Image size 2184x1690.
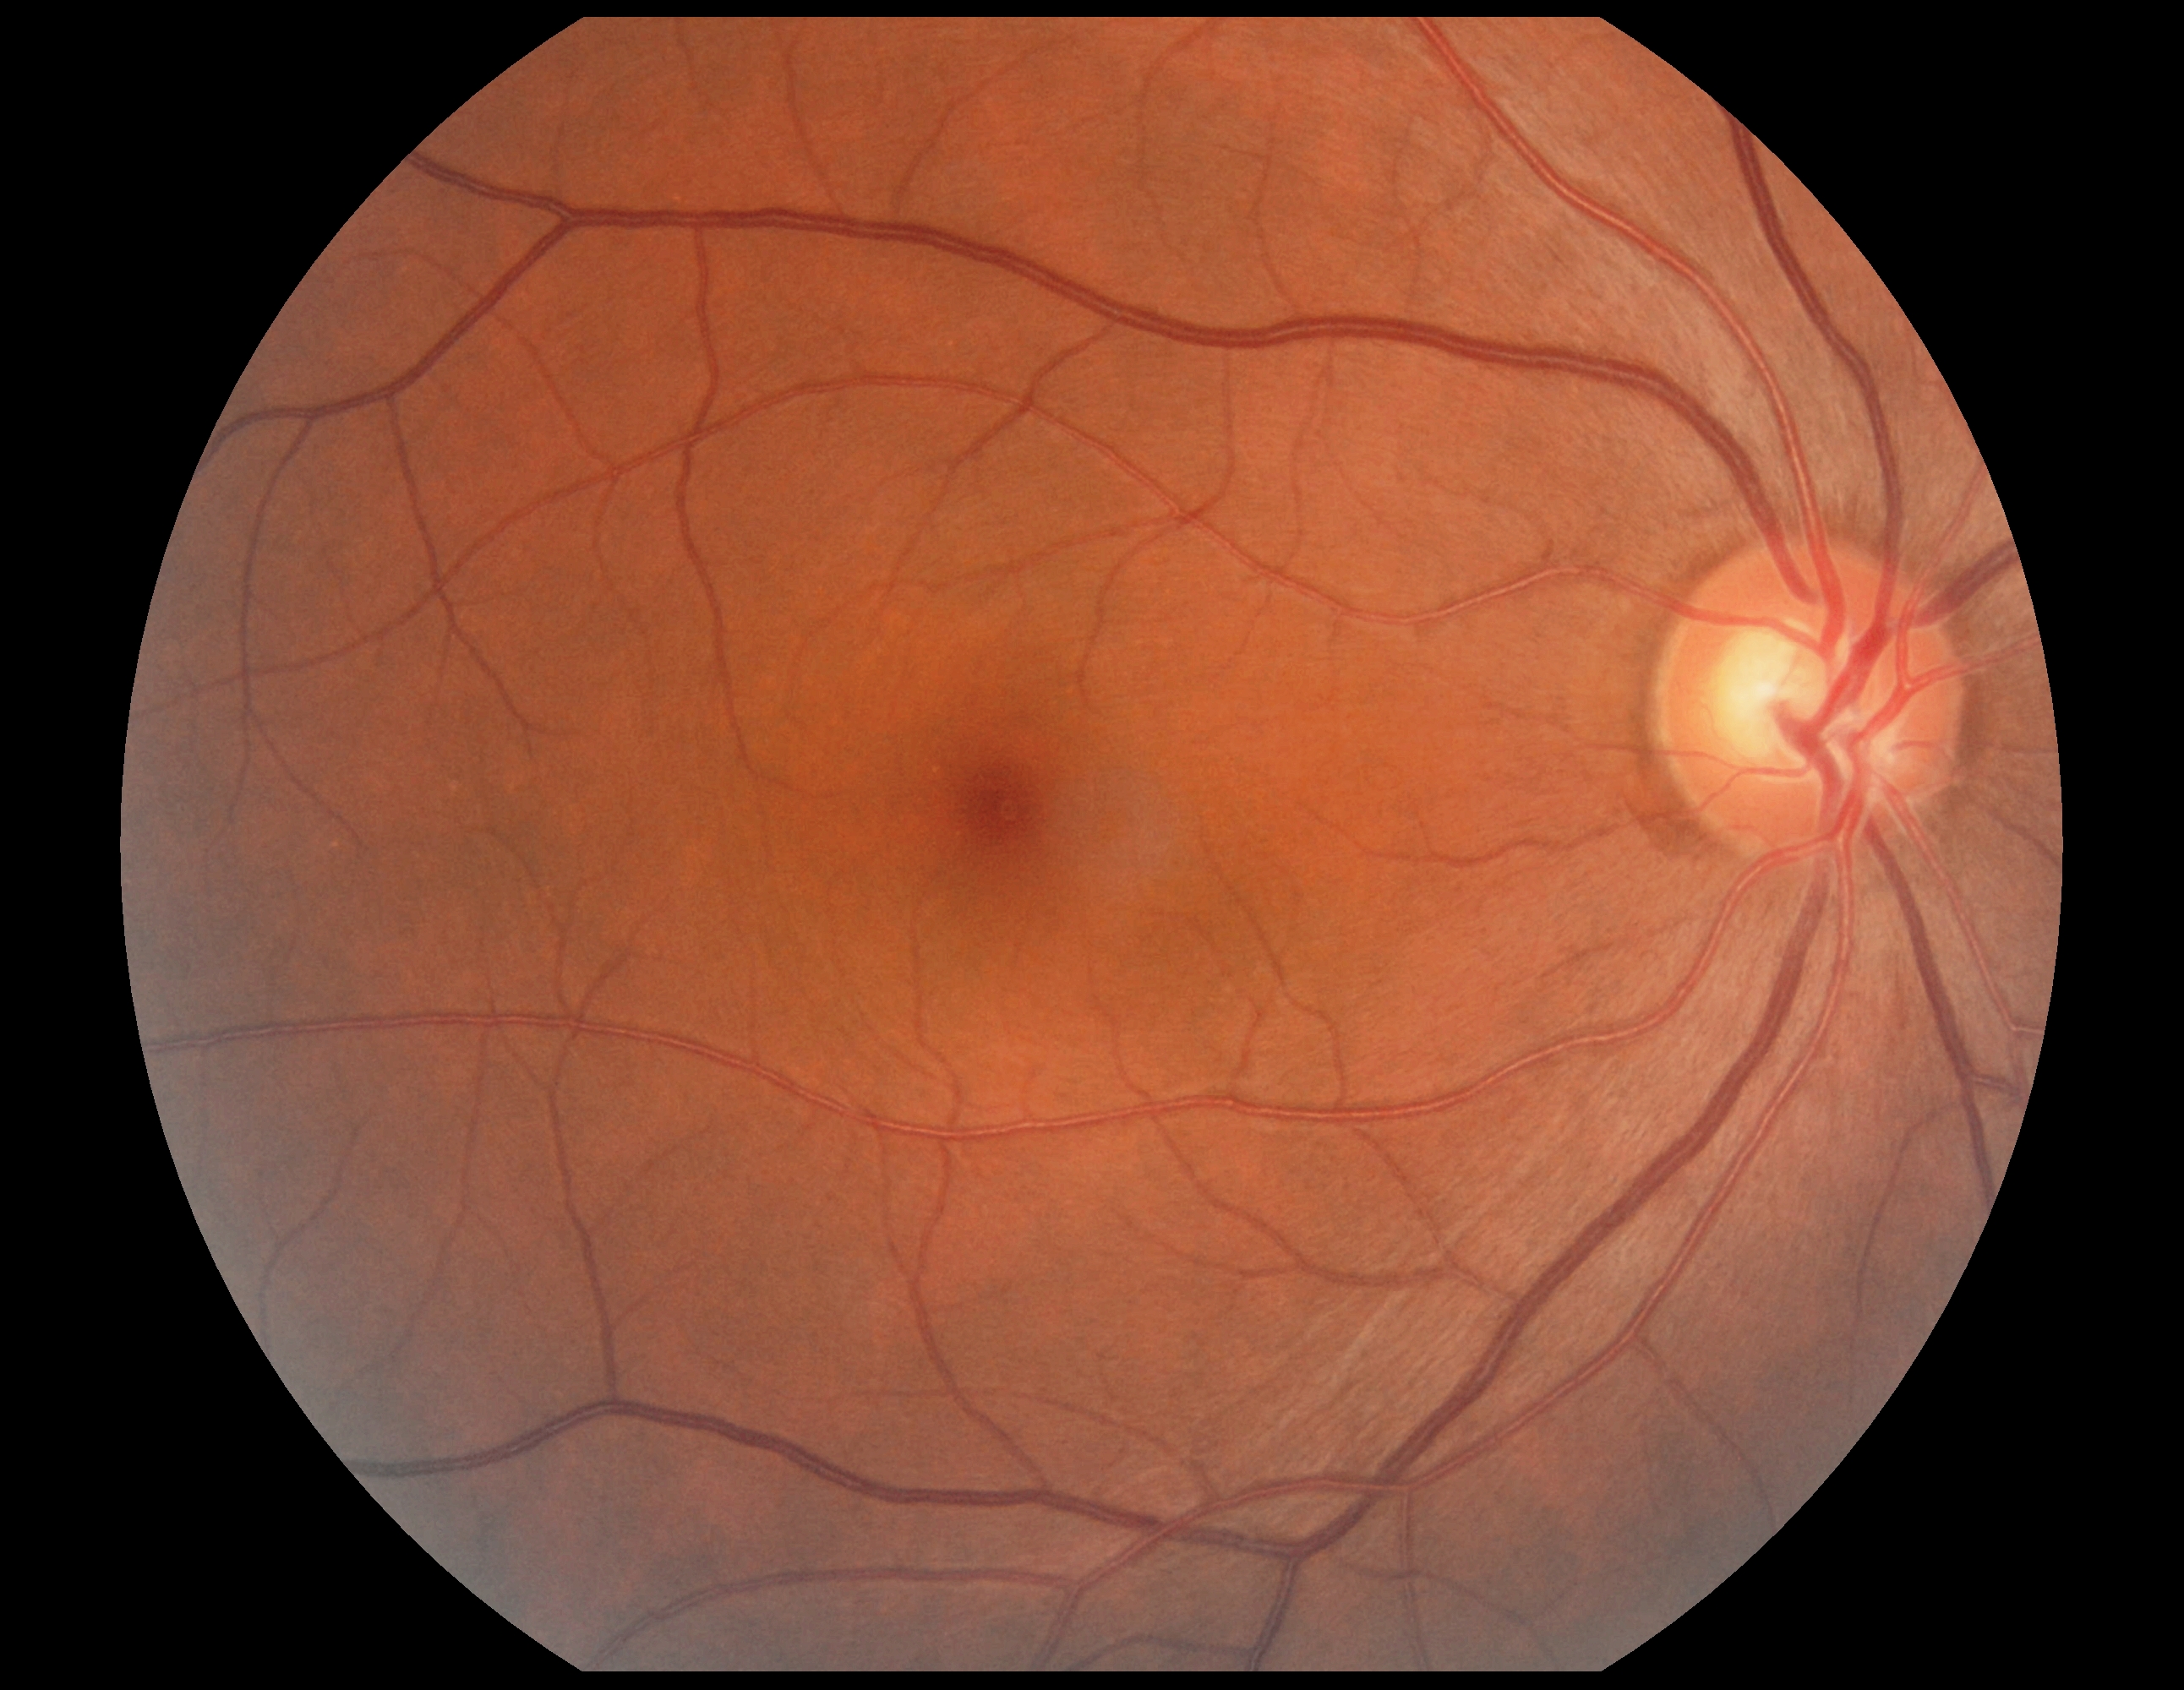

Diabetic retinopathy is grade 0 (no apparent retinopathy).
No DR findings.